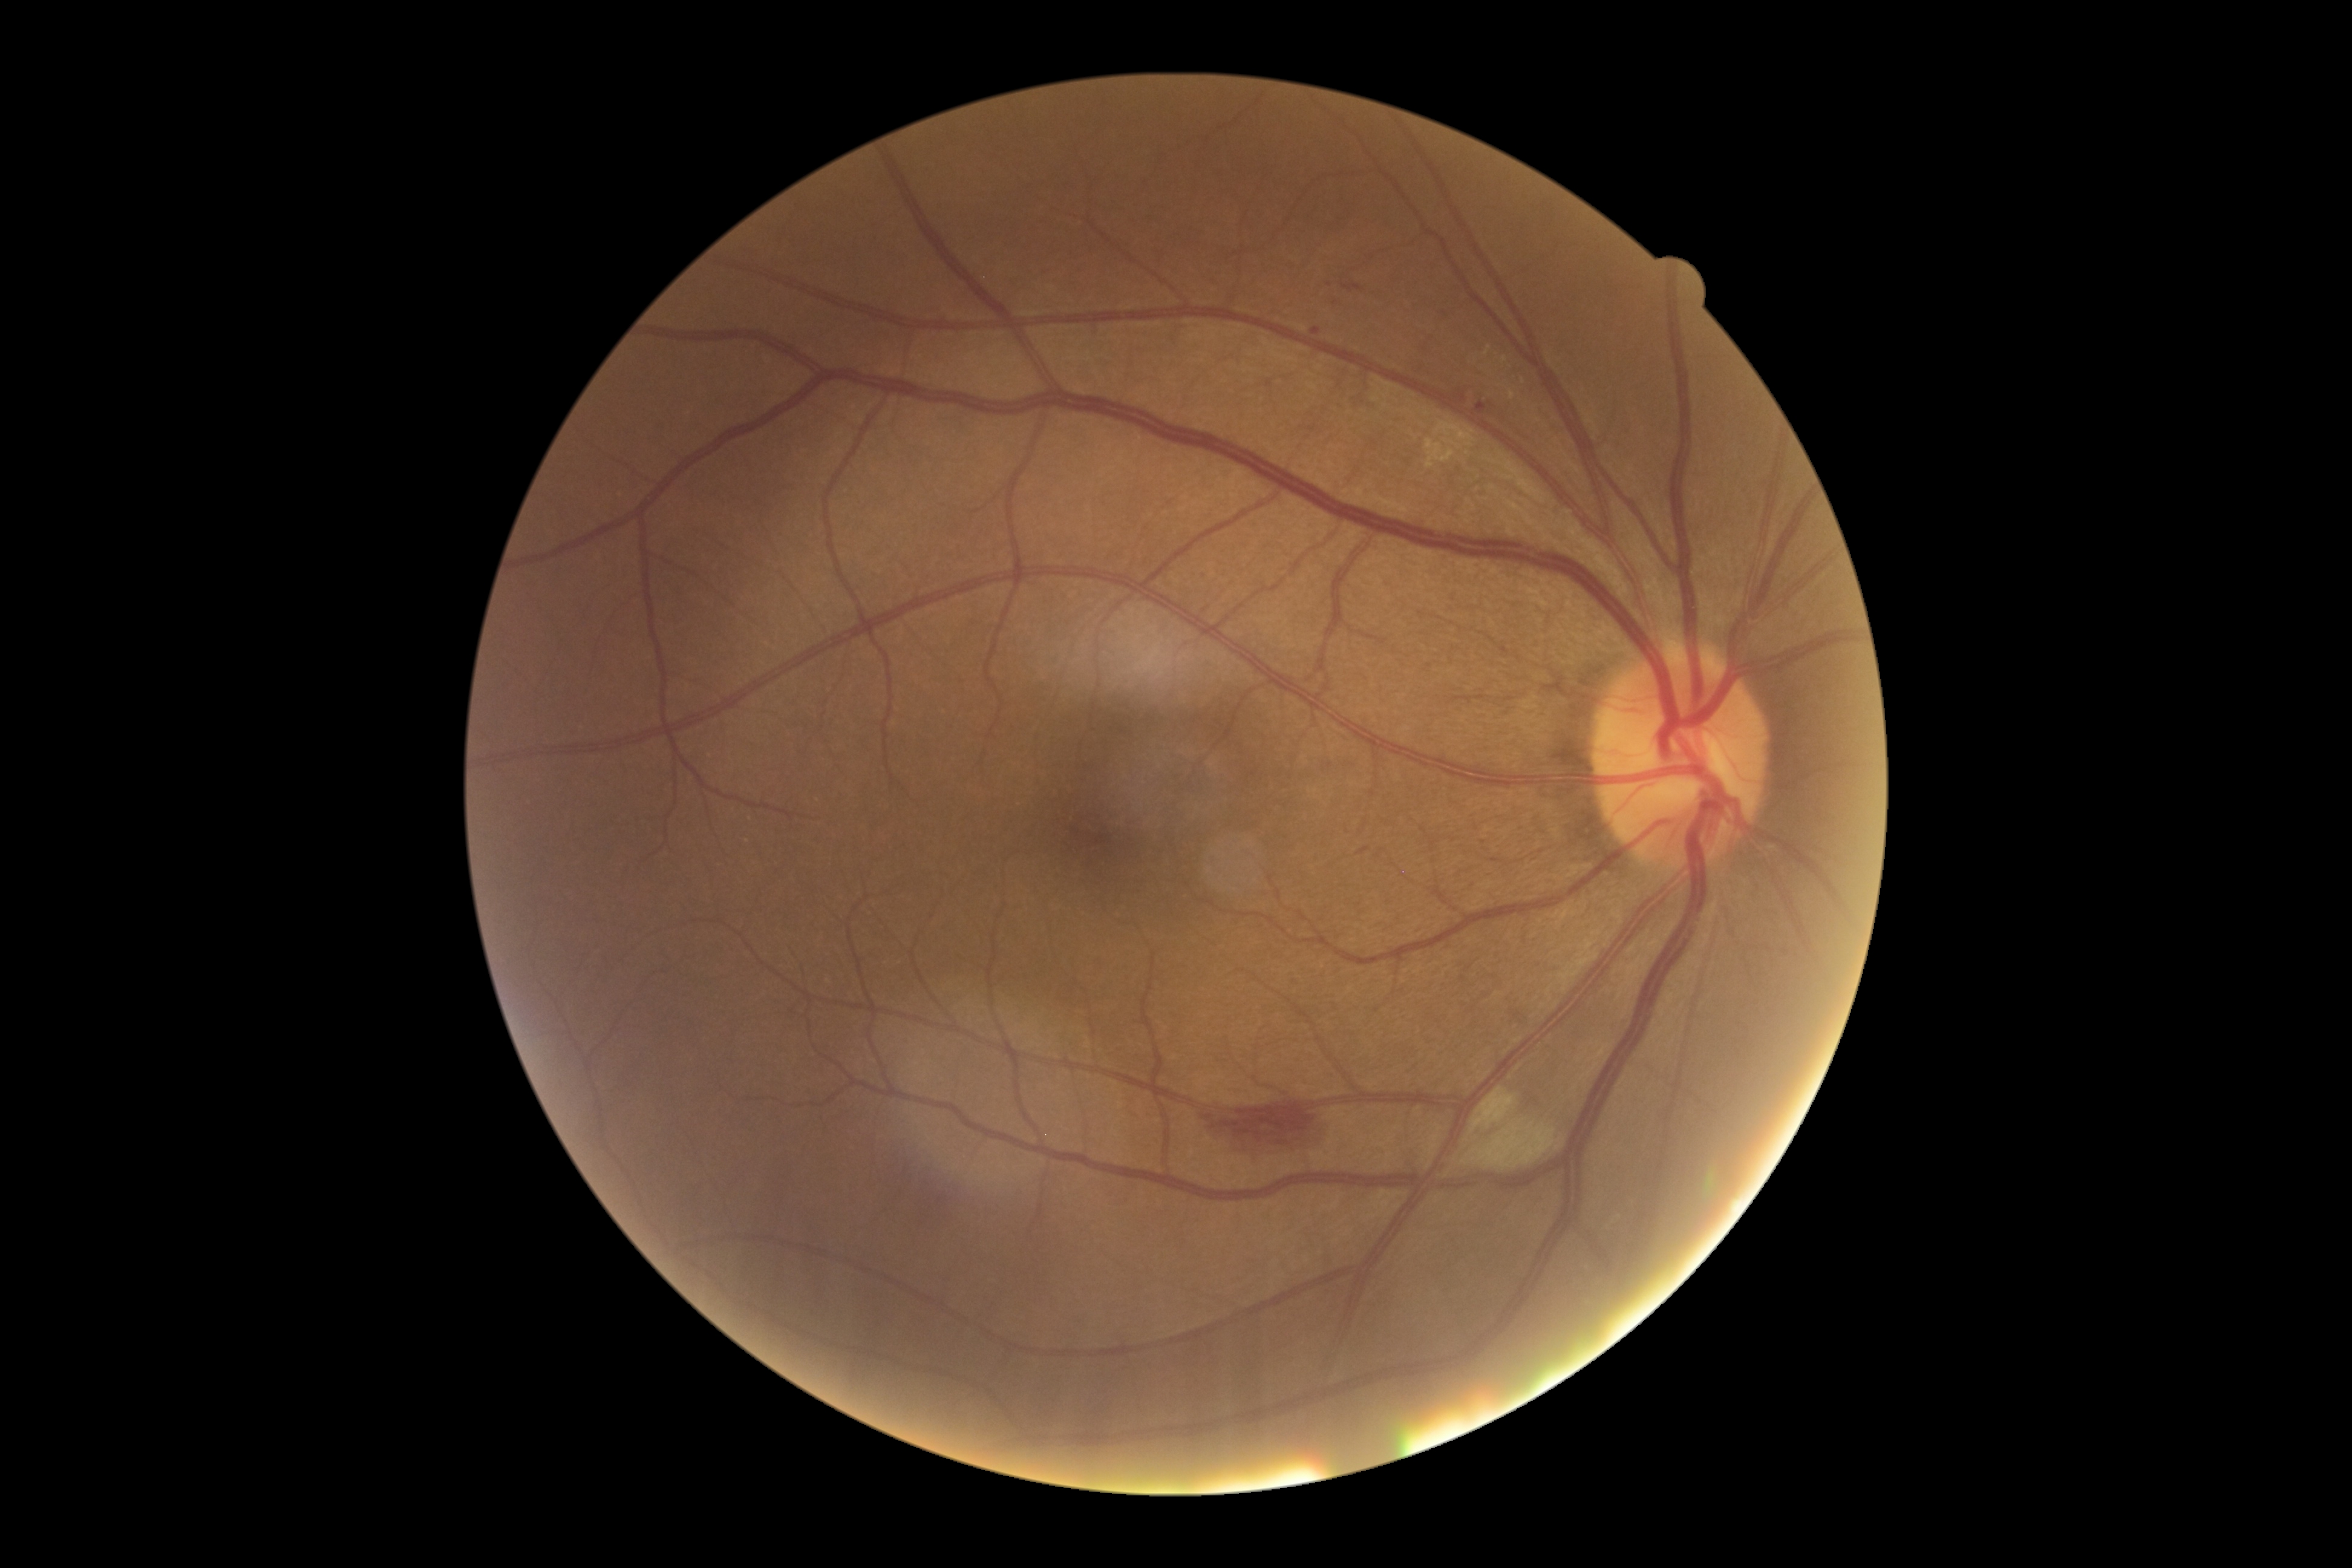

Diabetic retinopathy severity: 2.